Natus RetCam Envision, 130° FOV · wide-field fundus photograph from neonatal ROP screening · 1440 x 1080 pixels:
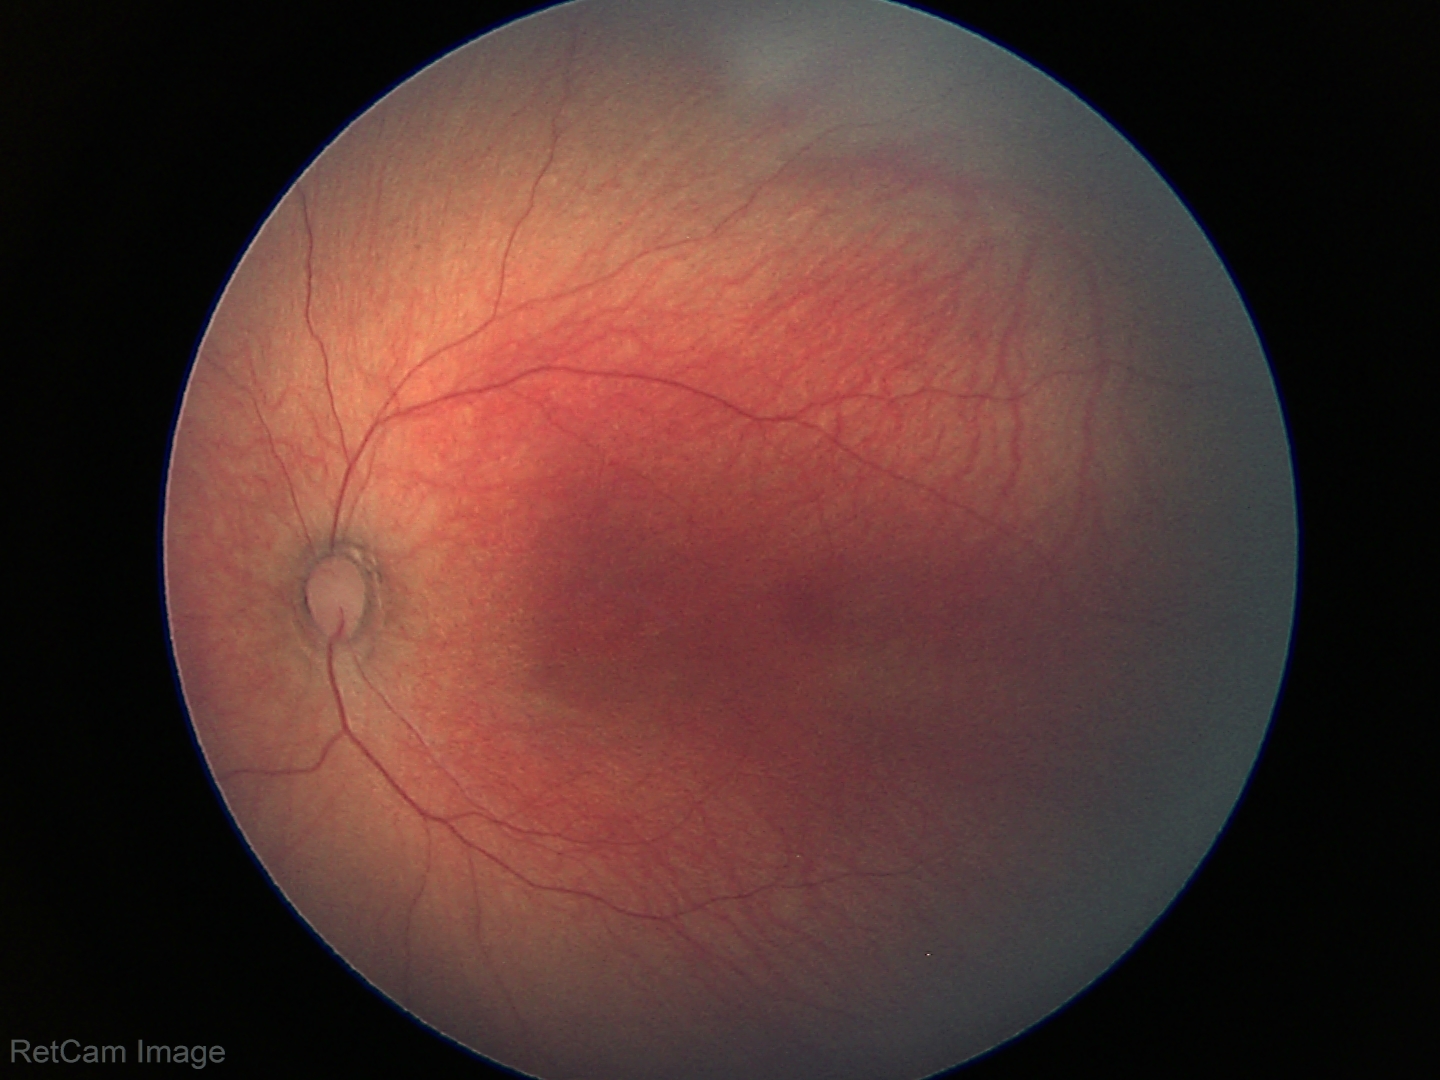

Impression = physiological appearance